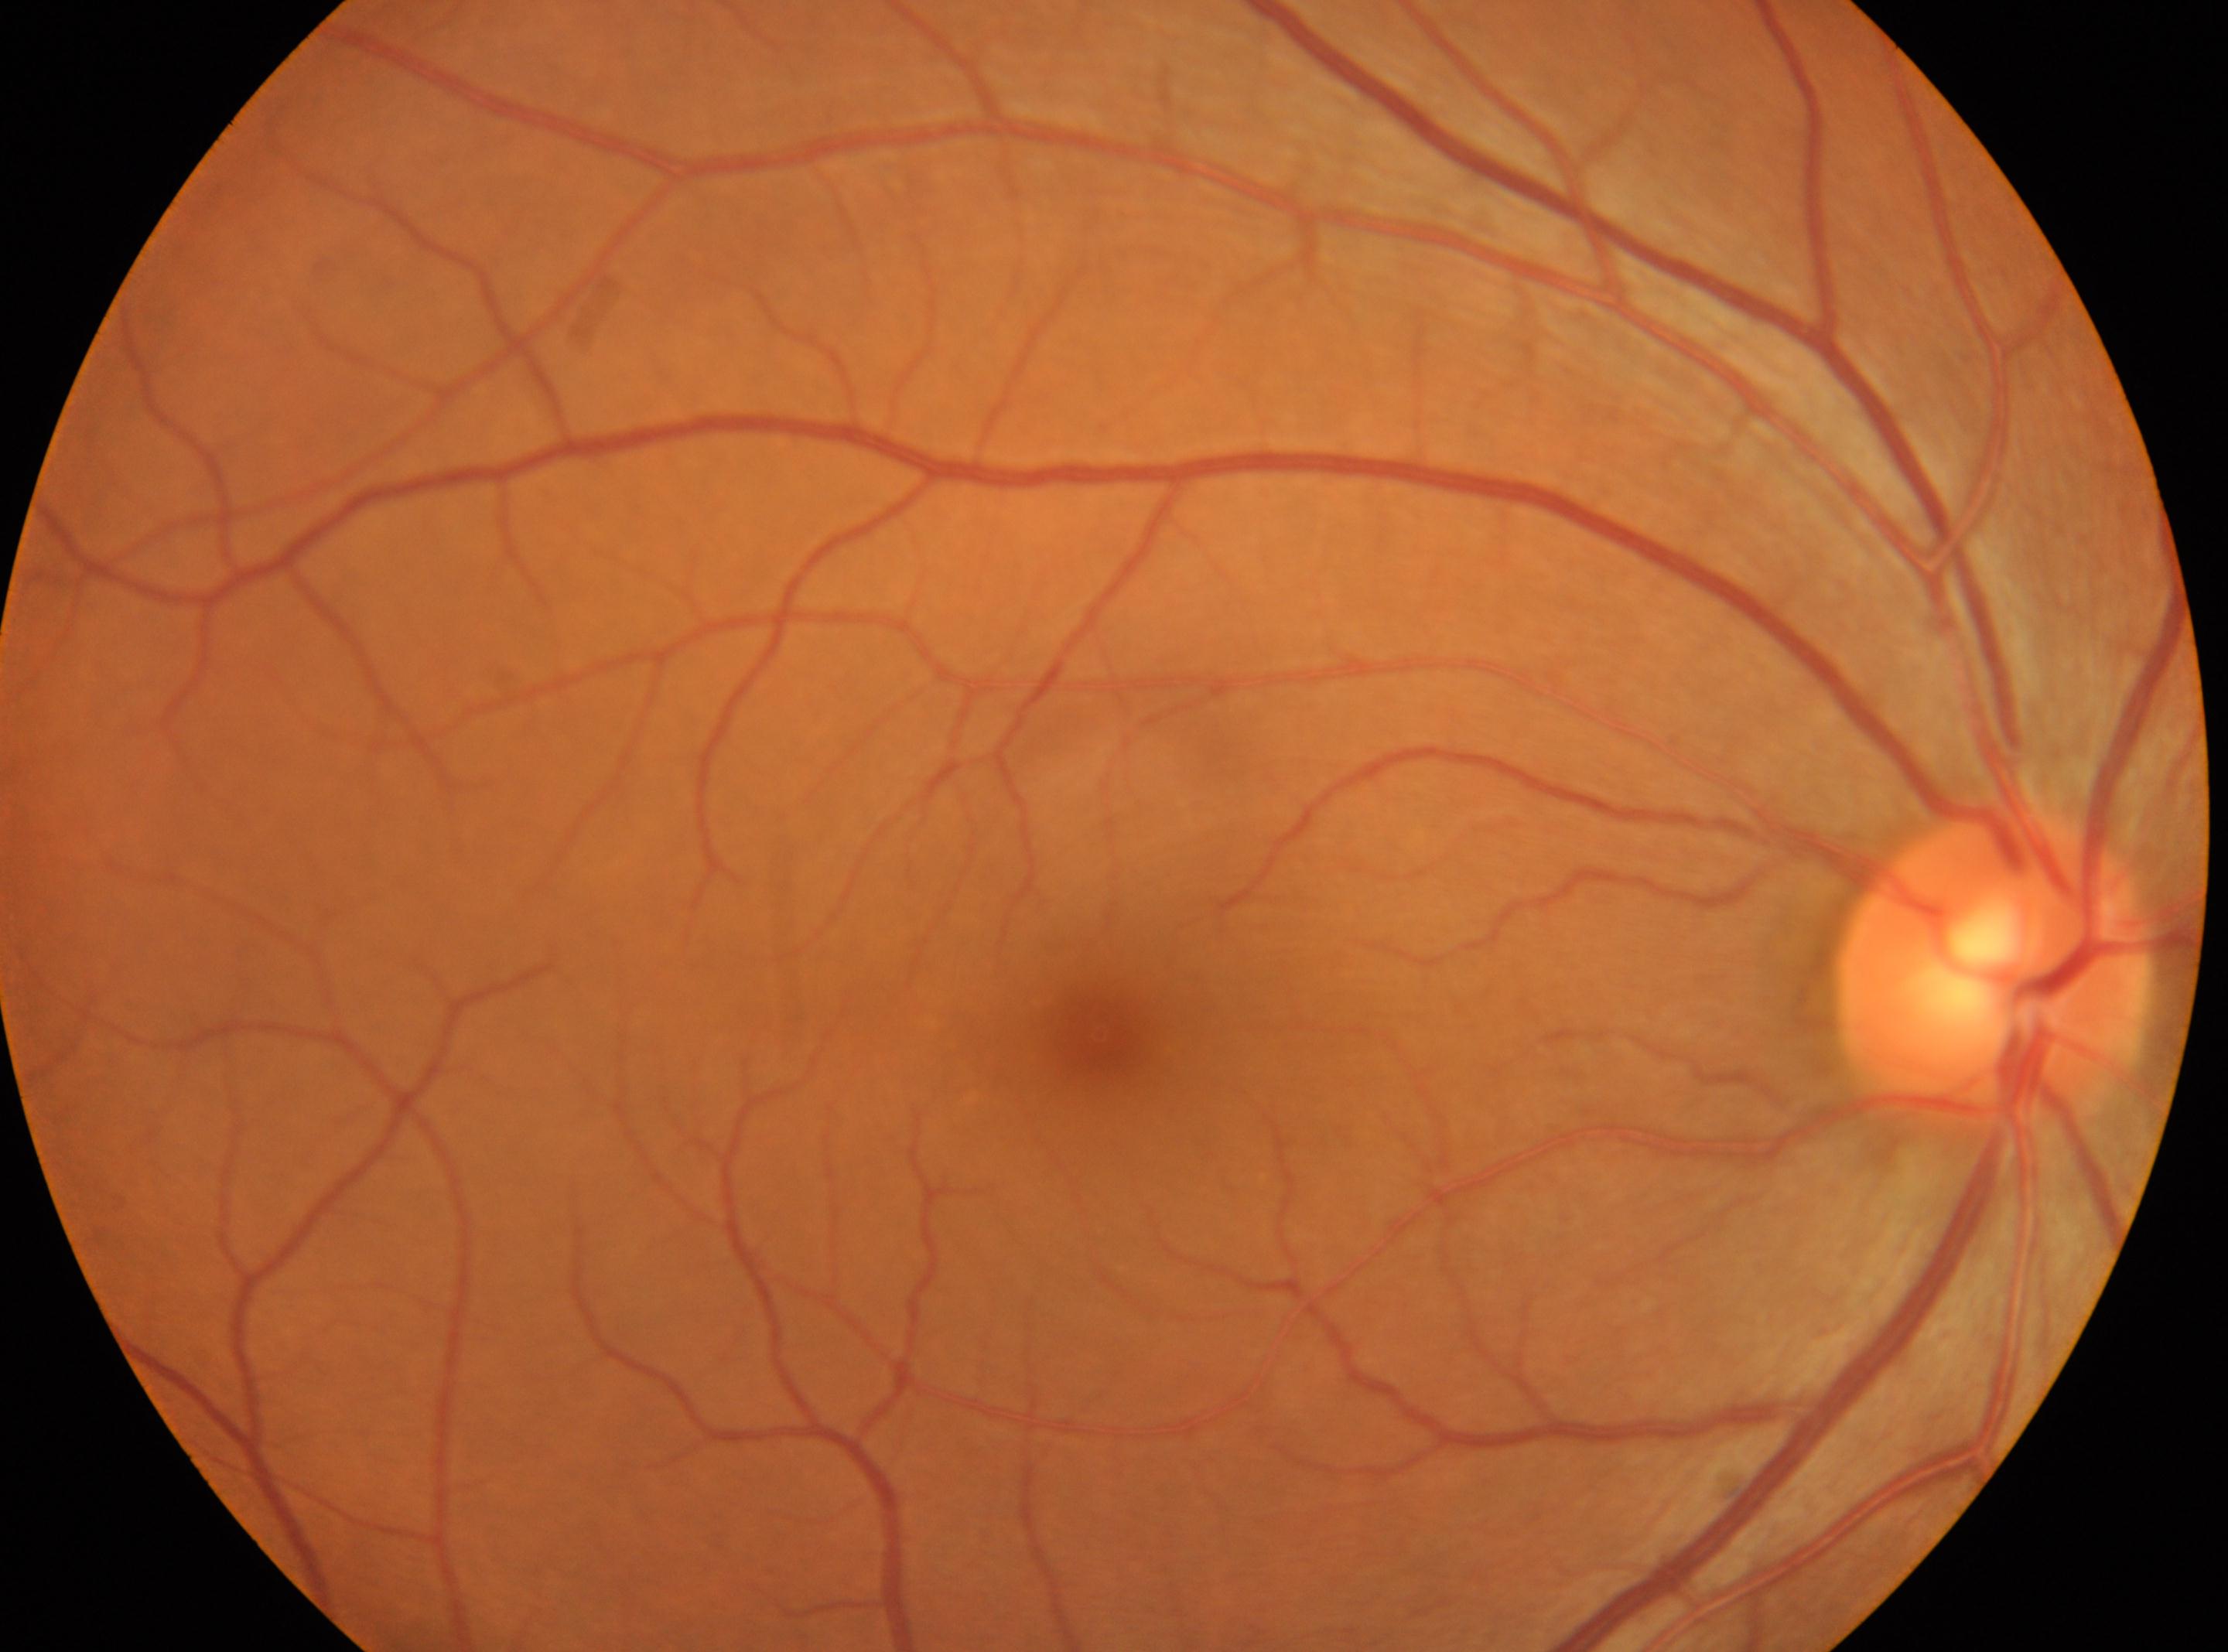 Q: Fovea center?
A: (x=1099, y=1035)
Q: What is the DR grade?
A: grade 0 (no apparent retinopathy)
Q: Which eye is imaged?
A: oculus dexter
Q: Locate the optic disc.
A: (x=1990, y=965)